Wide-field contact fundus photograph of an infant. 100° field of view (Phoenix ICON) — 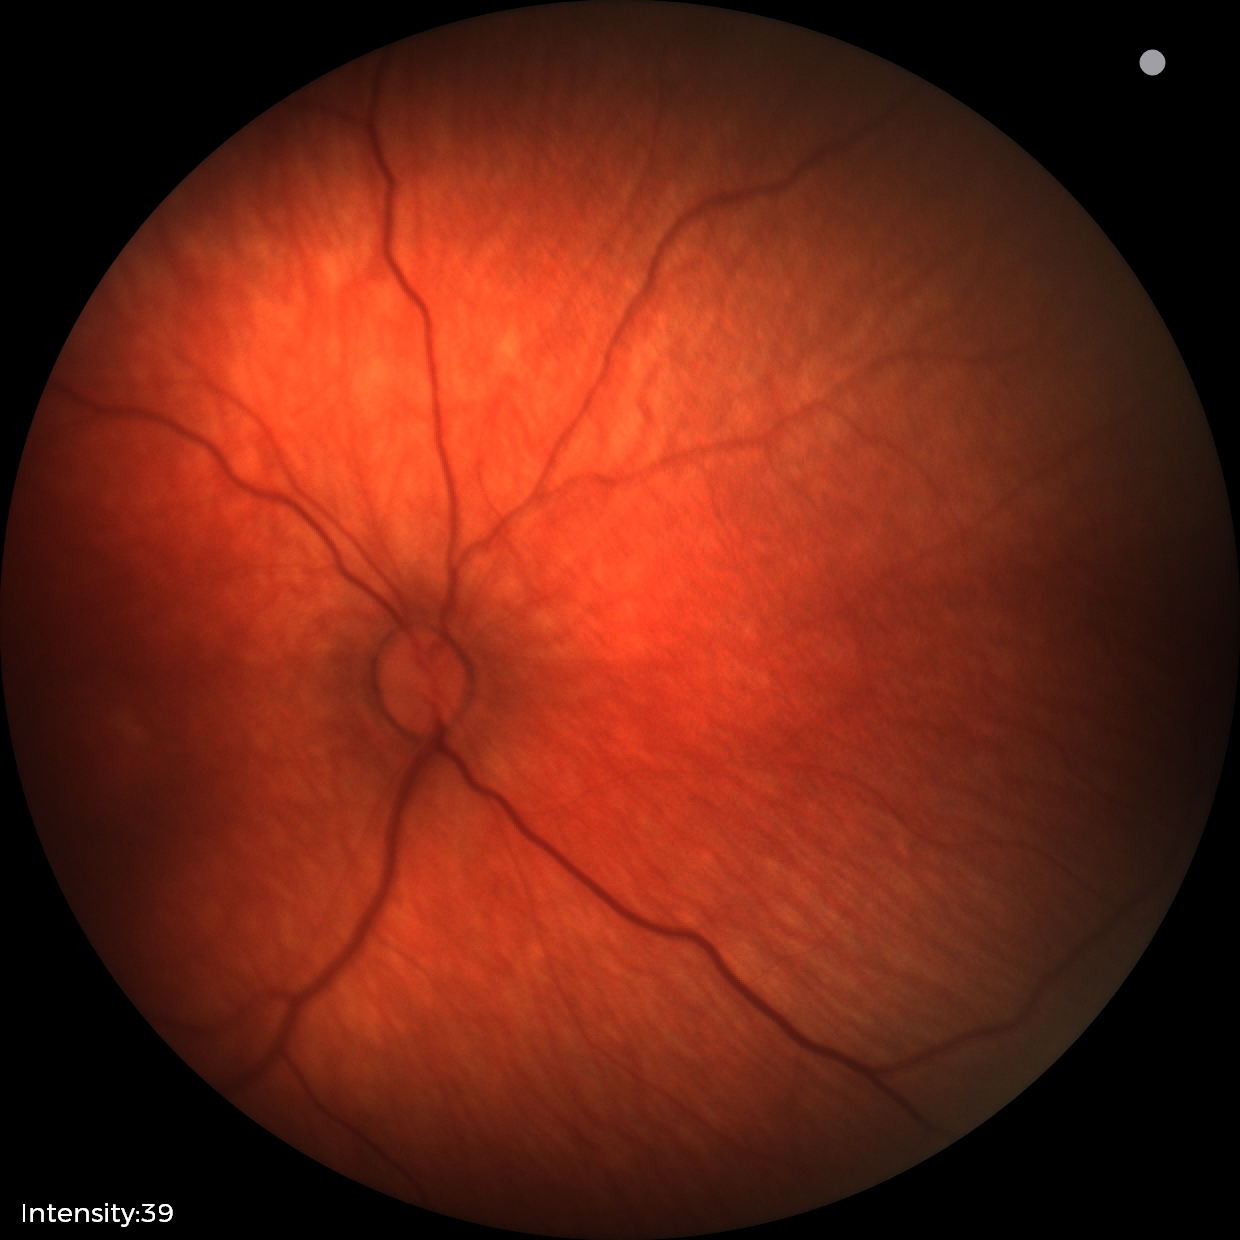 Screening diagnosis: physiological appearance with no retinal pathology.